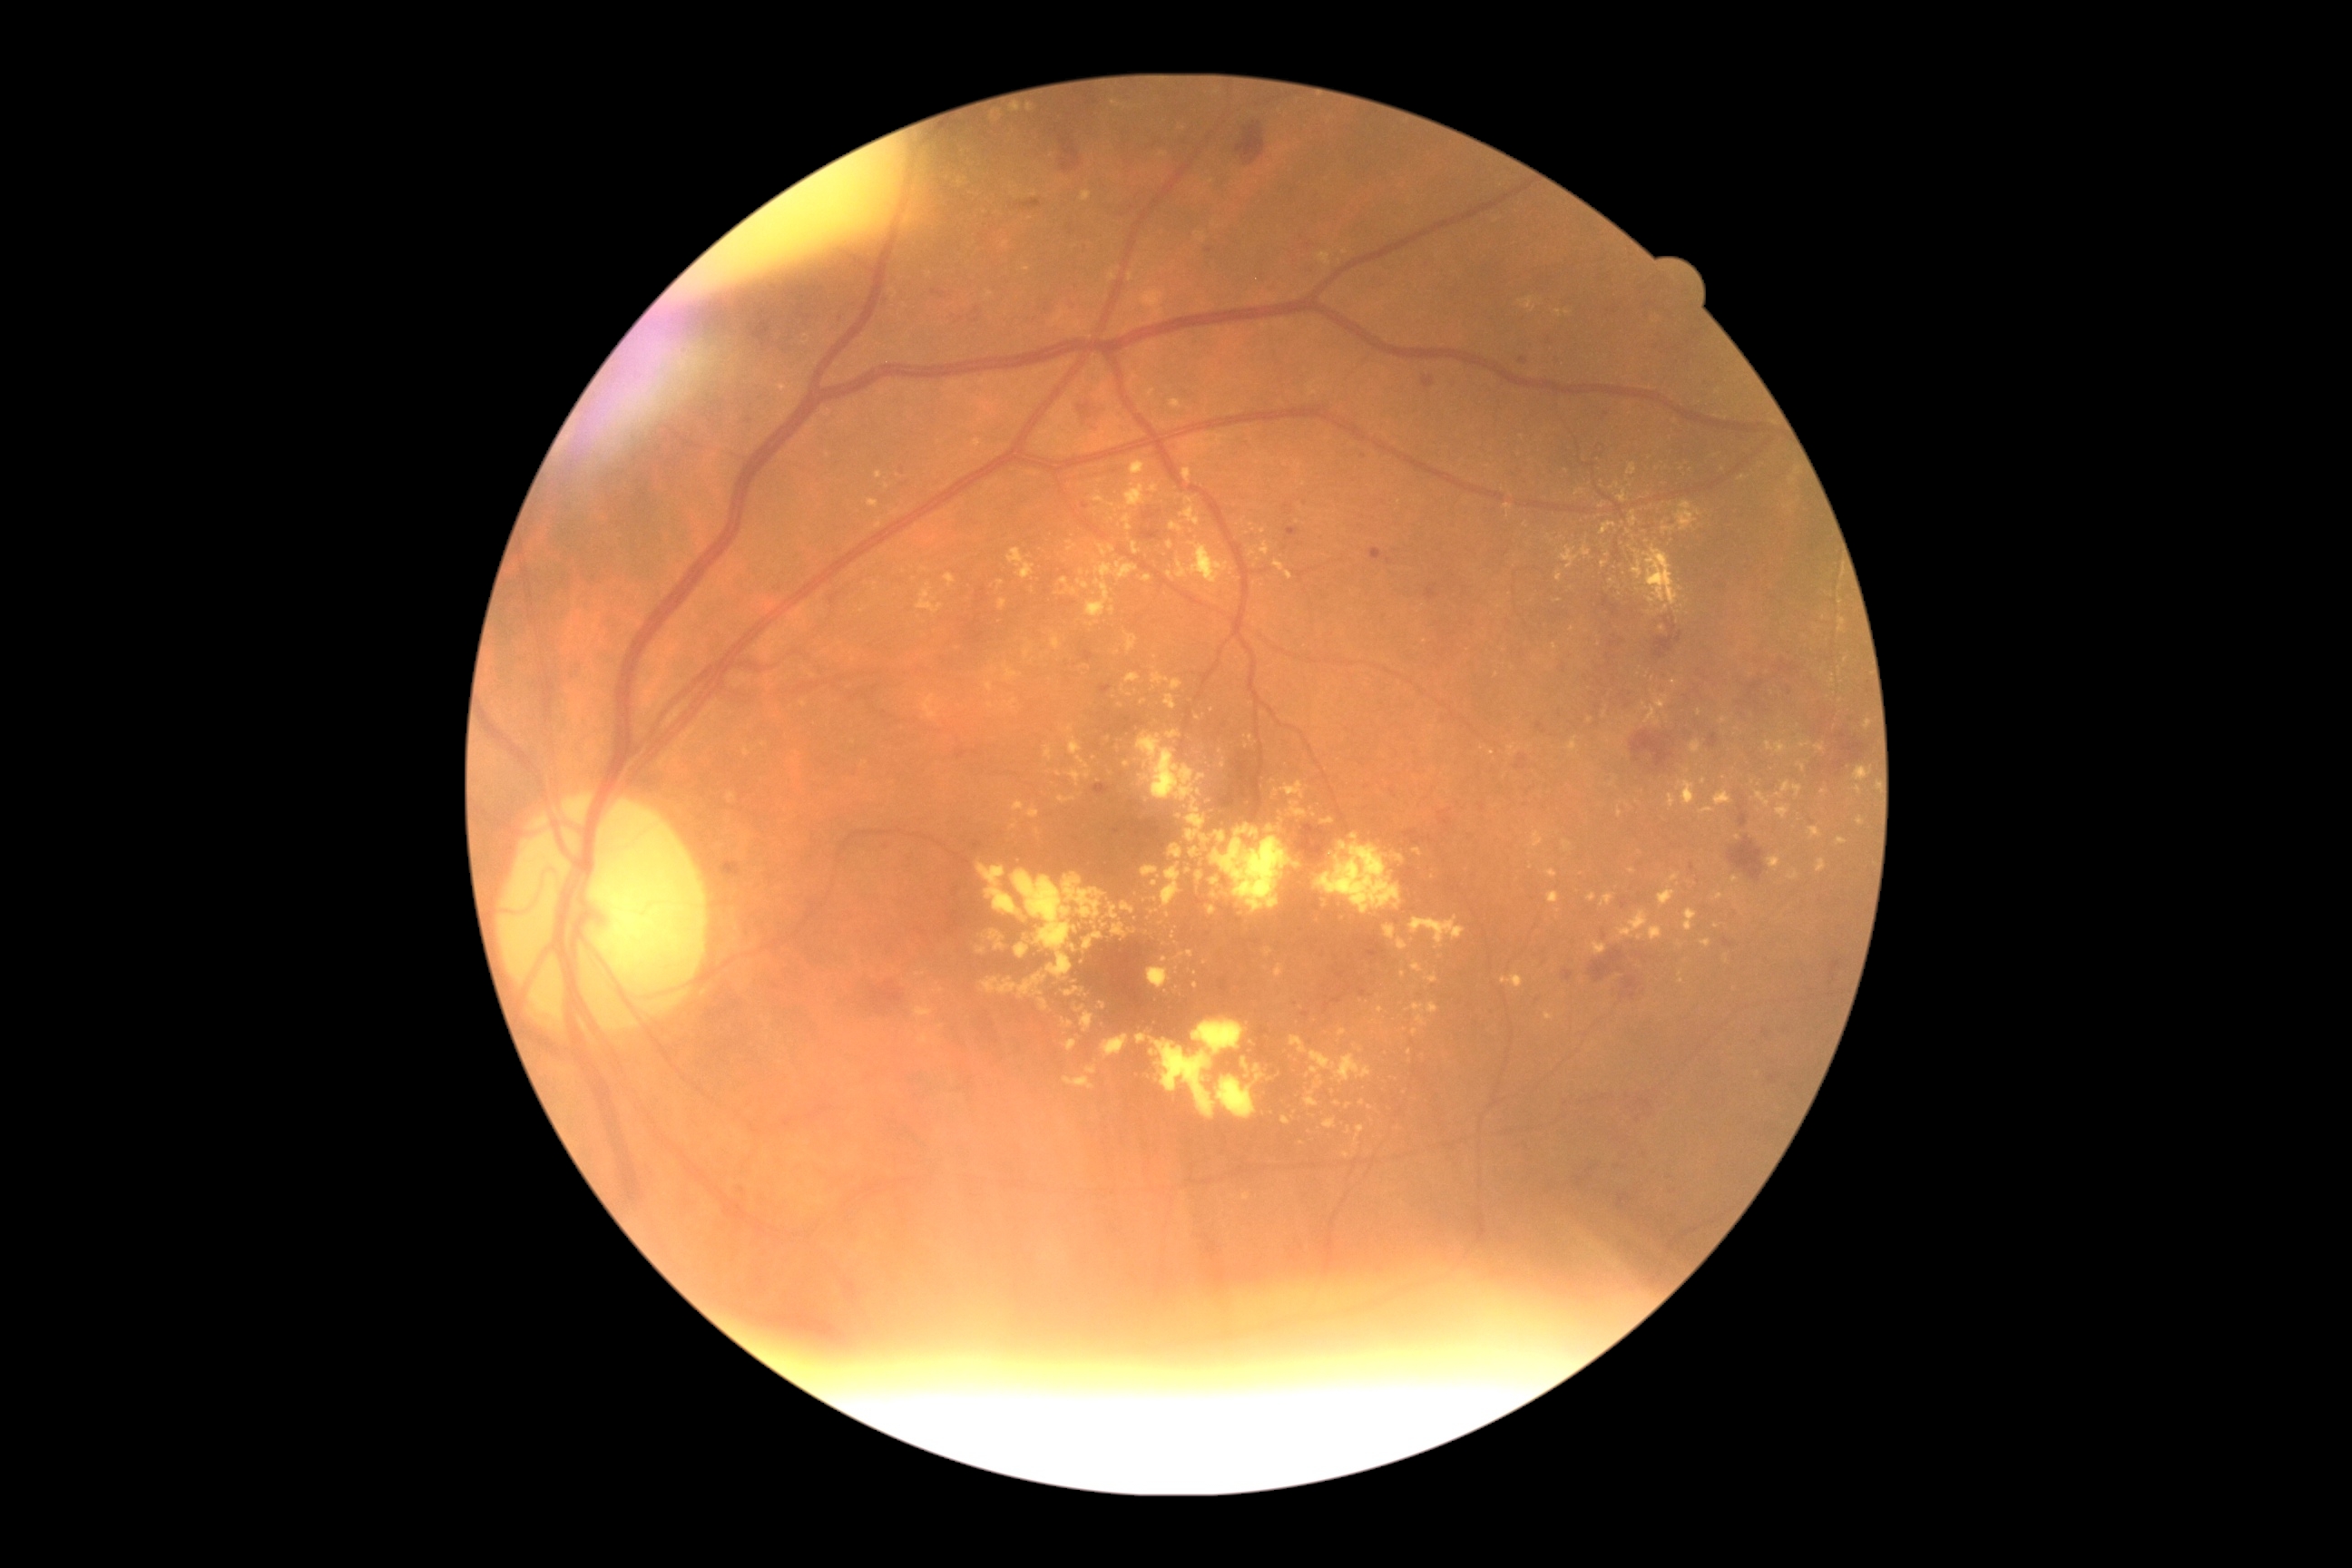 Diabetic retinopathy severity is 2
Lesions identified (partial list):
hard exudates (more not shown): <bbox>1086, 580, 1113, 618</bbox>, <bbox>1126, 484, 1146, 507</bbox>, <bbox>1631, 511, 1638, 527</bbox>, <bbox>1170, 522, 1184, 533</bbox>, <bbox>1170, 845, 1182, 859</bbox>, <bbox>1171, 950, 1193, 963</bbox>, <bbox>1547, 870, 1558, 879</bbox>, <bbox>1426, 974, 1438, 985</bbox>, <bbox>1338, 1028, 1348, 1037</bbox>, <bbox>1026, 104, 1034, 113</bbox>, <bbox>1003, 242, 1010, 250</bbox>, <bbox>1128, 273, 1133, 282</bbox>
Additional small hard exudates near [x=1662, y=629], [x=1177, y=944], [x=1647, y=542], [x=991, y=707], [x=1675, y=683], [x=1415, y=1031], [x=1197, y=718]